Dilated-pupil acquisition
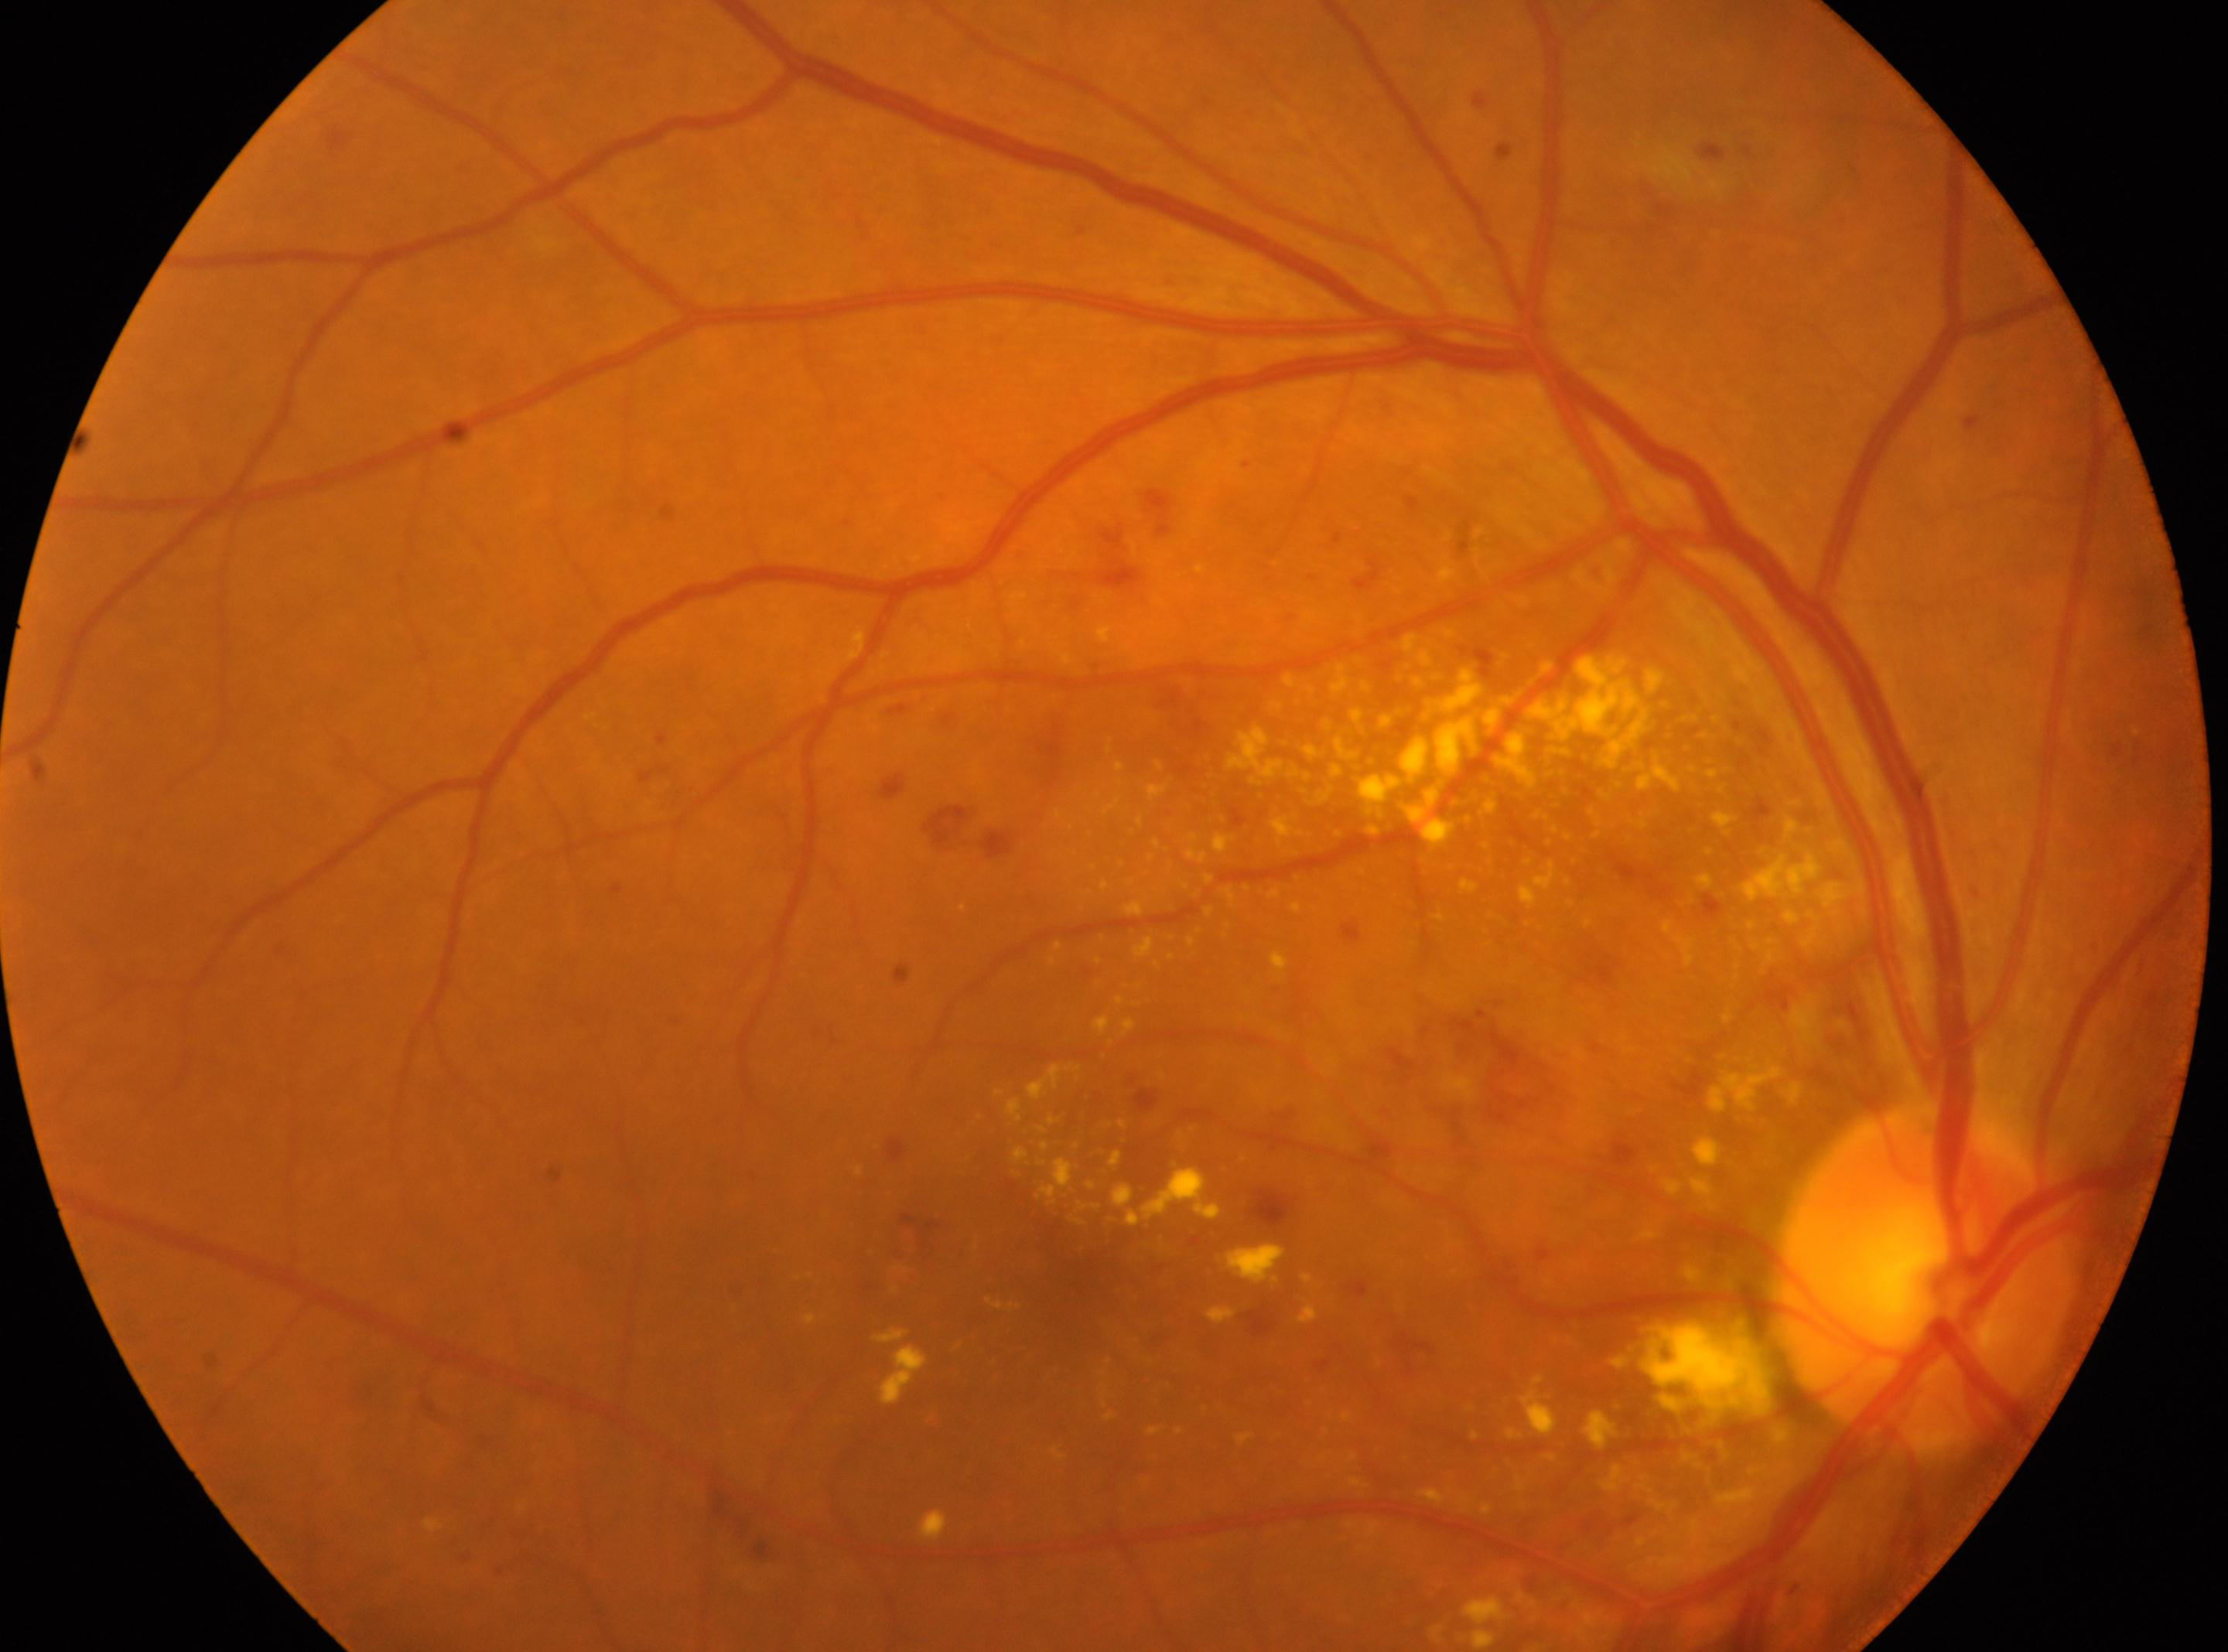

laterality = right eye
optic disc = (1924, 1277)
DR class = non-proliferative diabetic retinopathy
macular center = (1068, 1268)
retinopathy = moderate non-proliferative diabetic retinopathy (grade 2)